Pediatric wide-field fundus photograph: 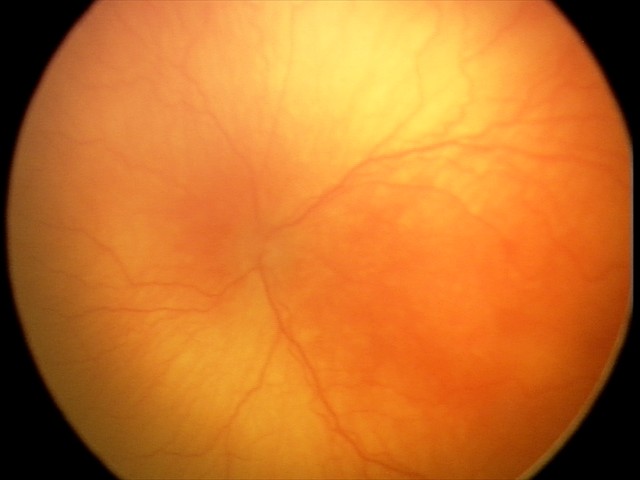

Impression: aggressive retinopathy of prematurity.